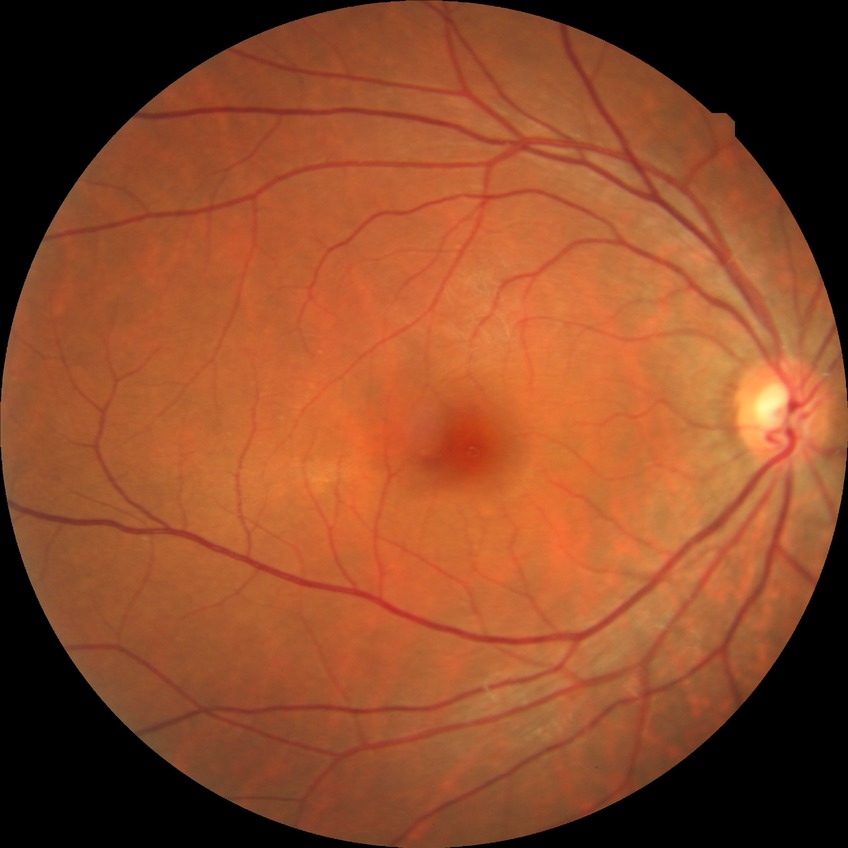
No apparent diabetic retinopathy. Davis DR grade is NDR.